Image size 640x480 · acquired on the Clarity RetCam 3 · RetCam wide-field infant fundus image: 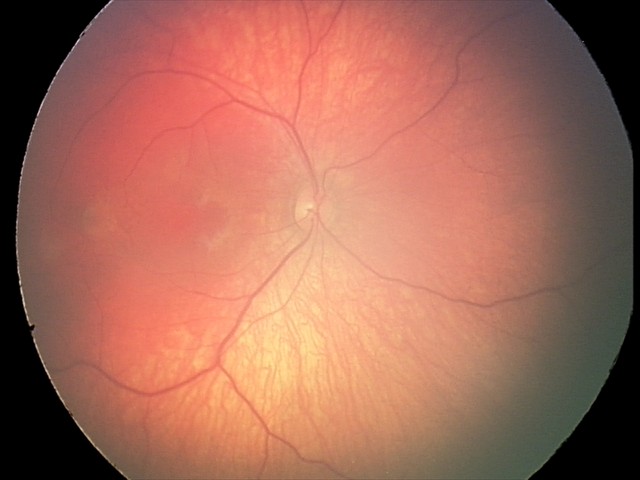

Screening diagnosis: retinal hemorrhages.